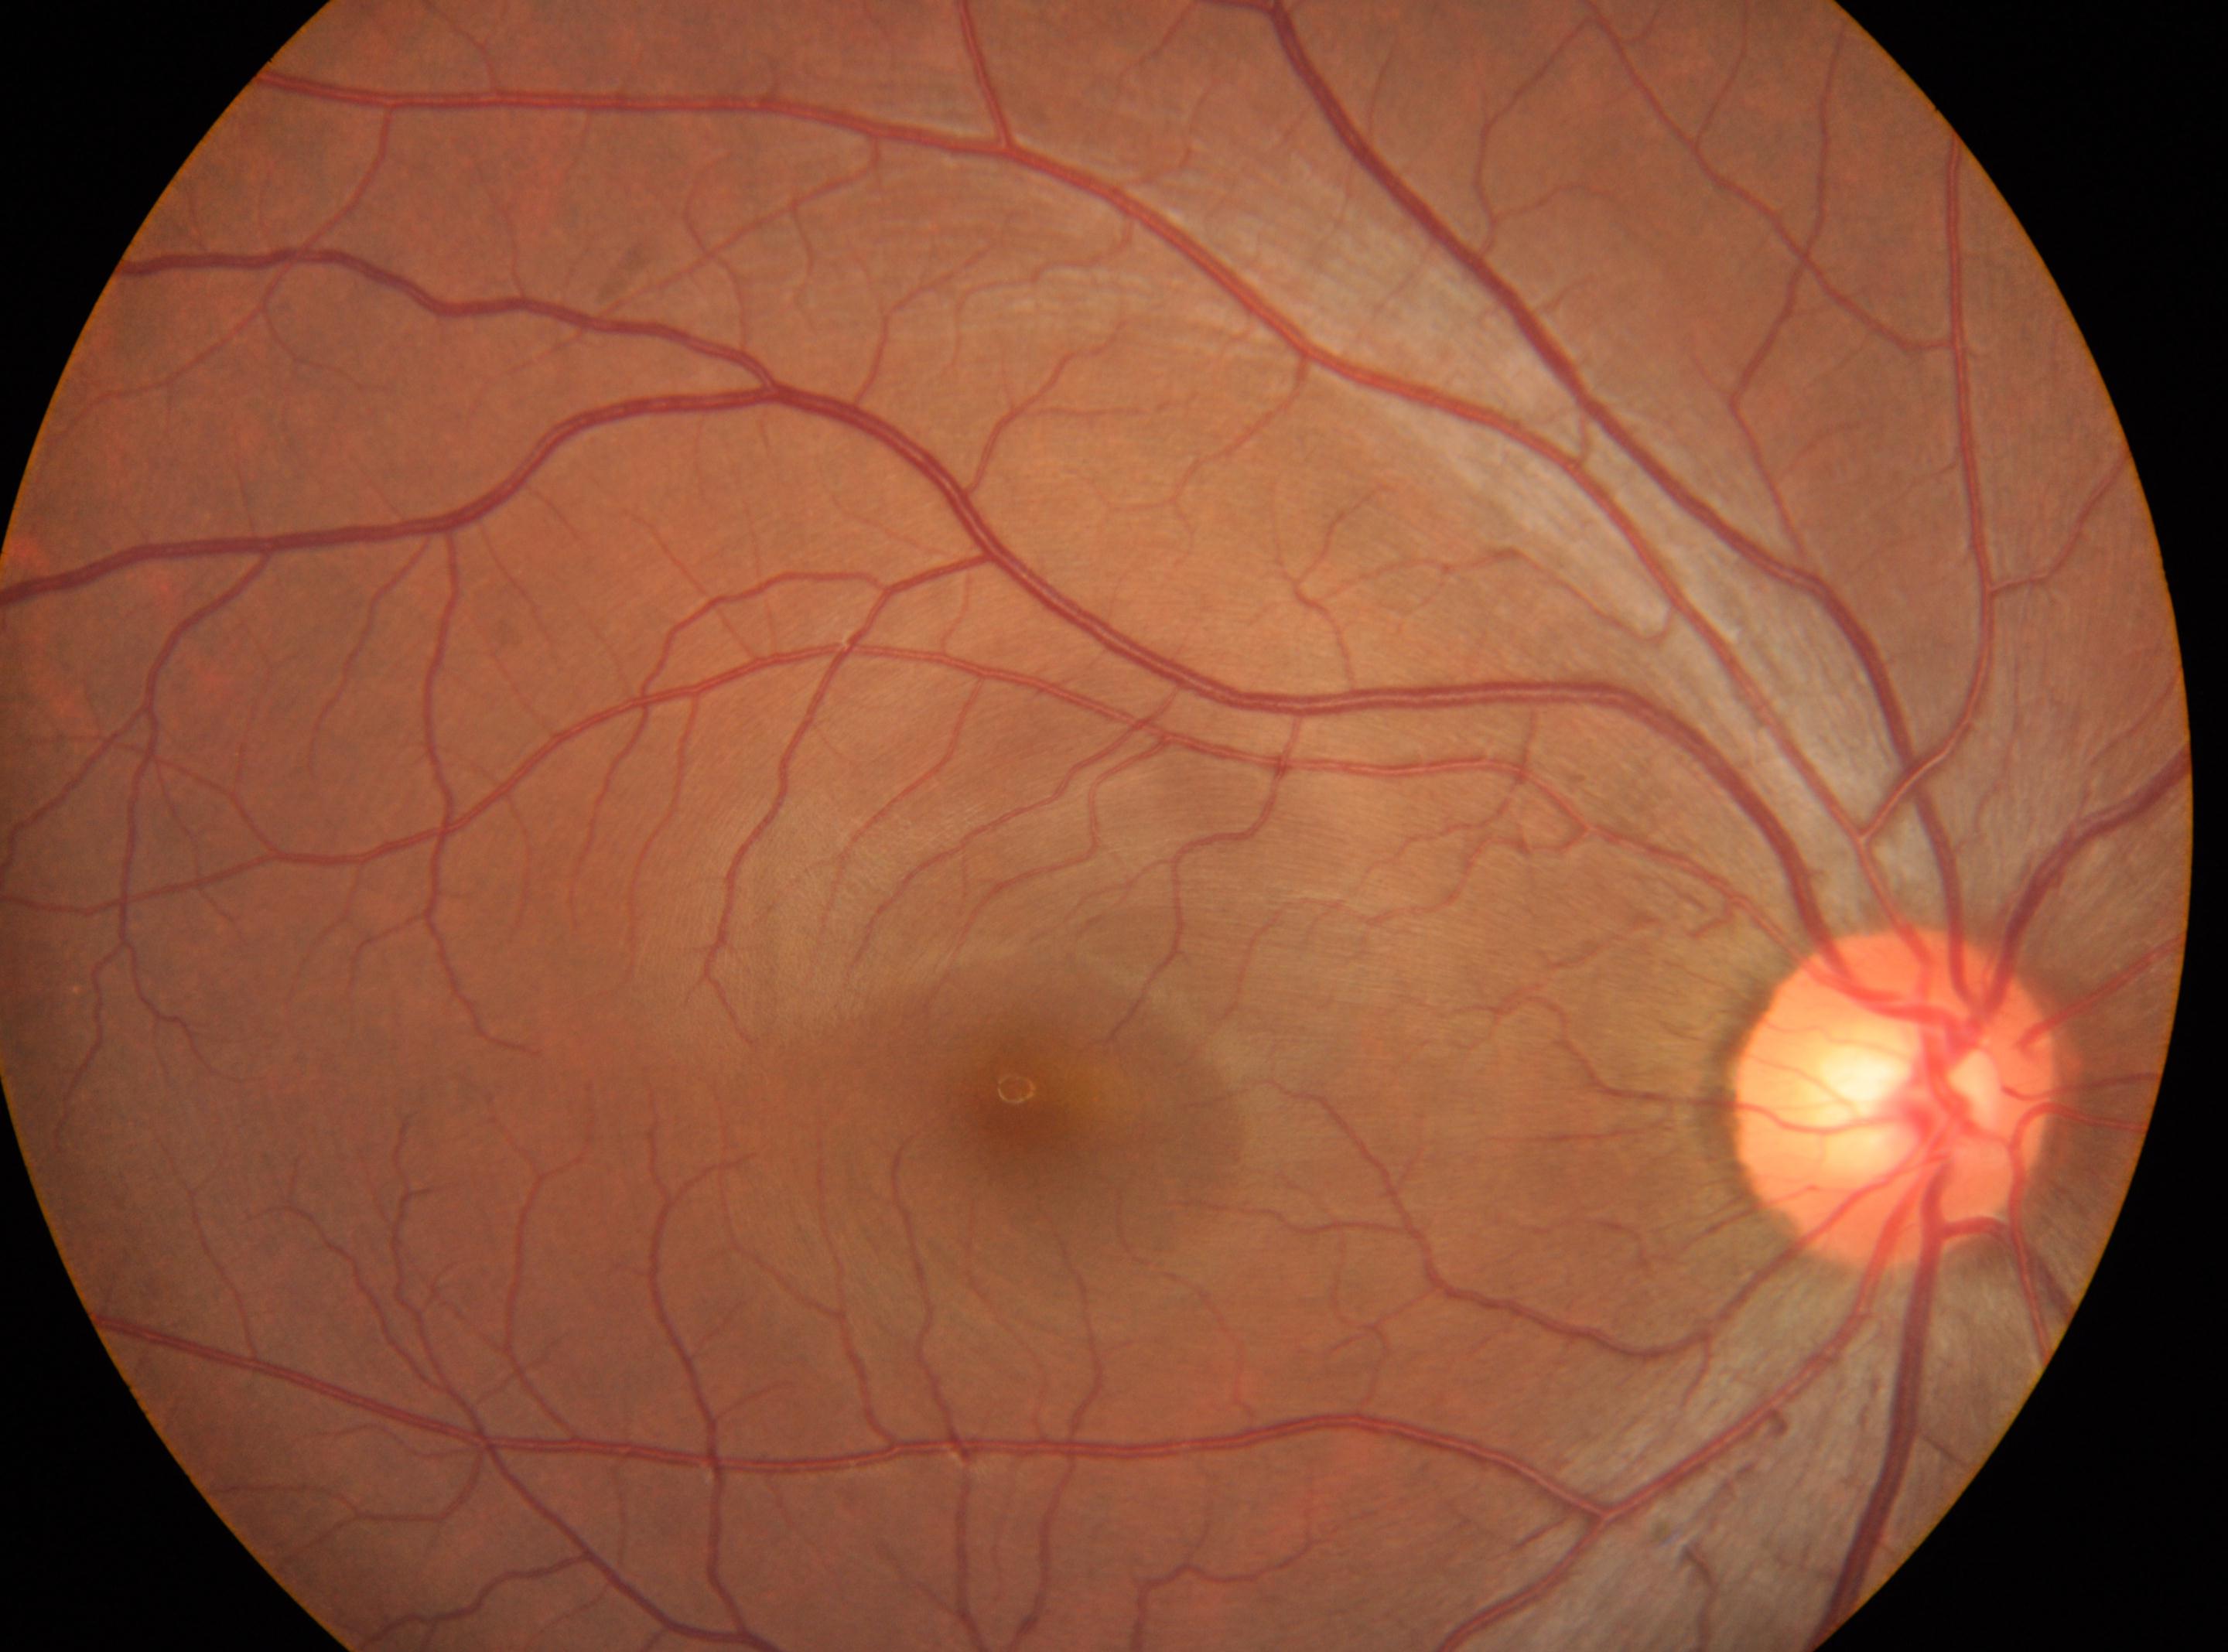
• the optic disc: (1891,1097)
• DR severity: 0/4
• the fovea: (1021,1104)
• laterality: the right eye